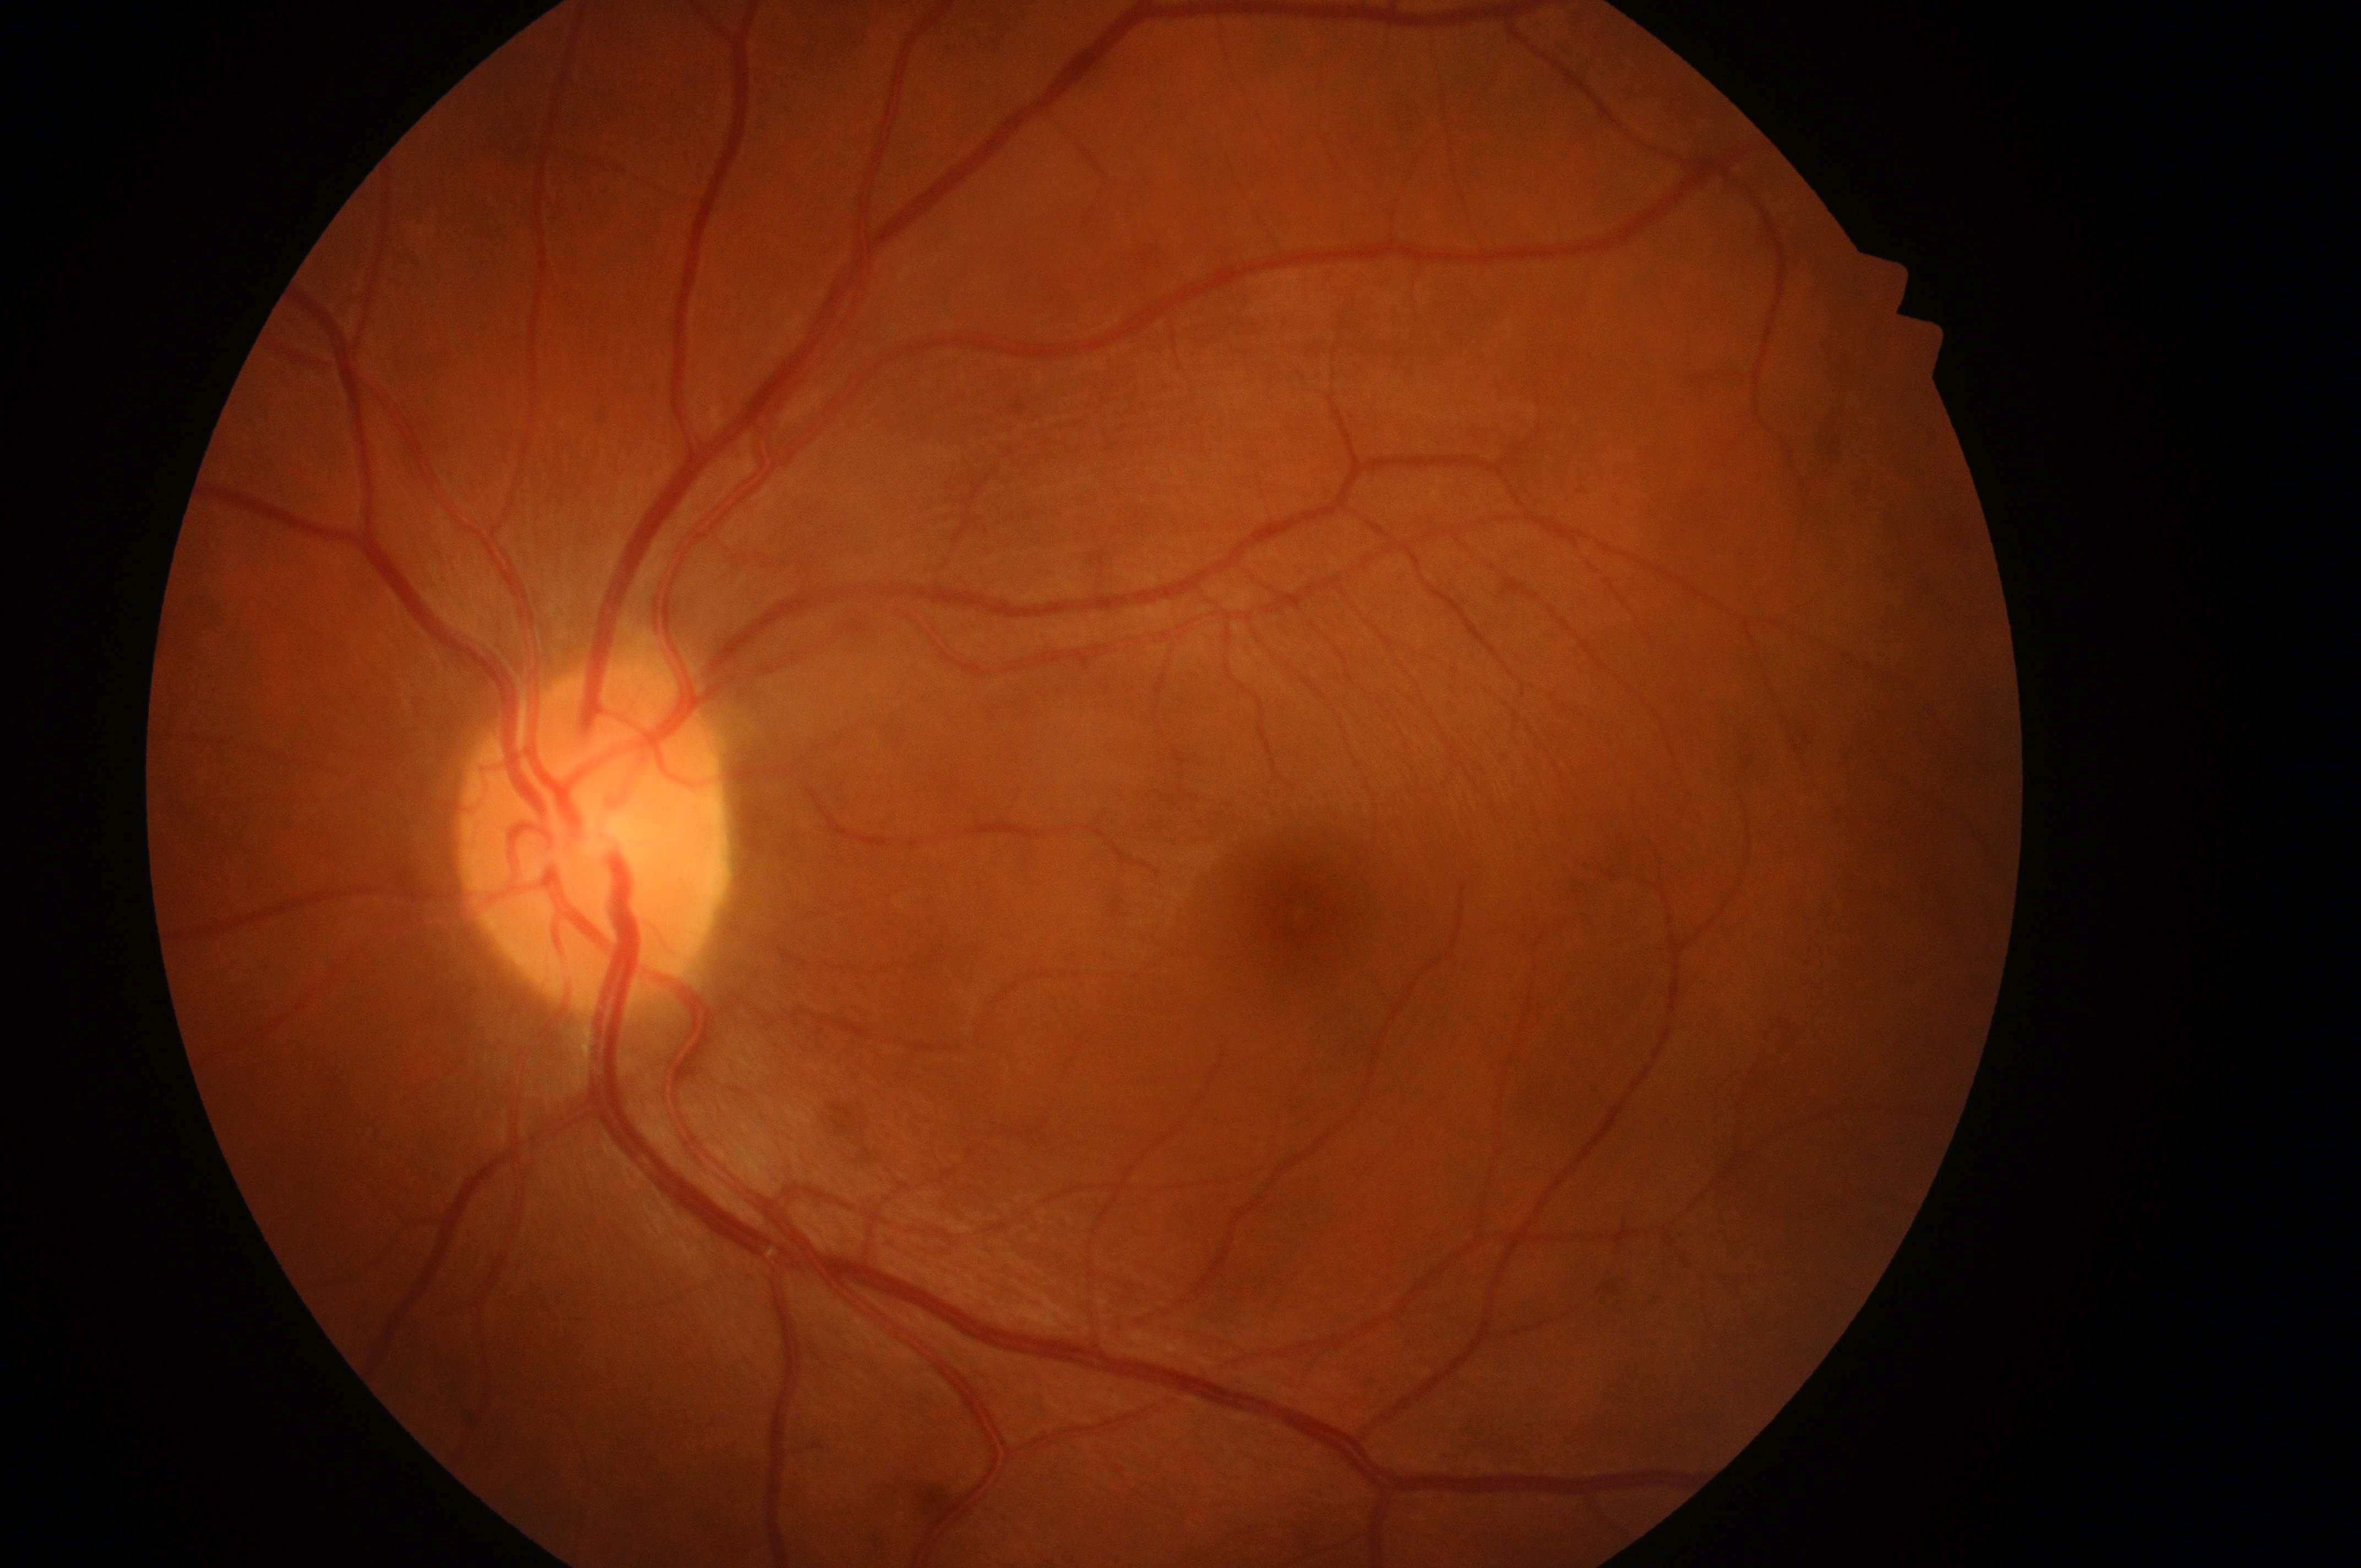
DME = no risk (grade 0)
laterality = left eye
the optic disc = 592px, 858px
fovea = 1299px, 911px
DR = grade 0 (no apparent retinopathy)